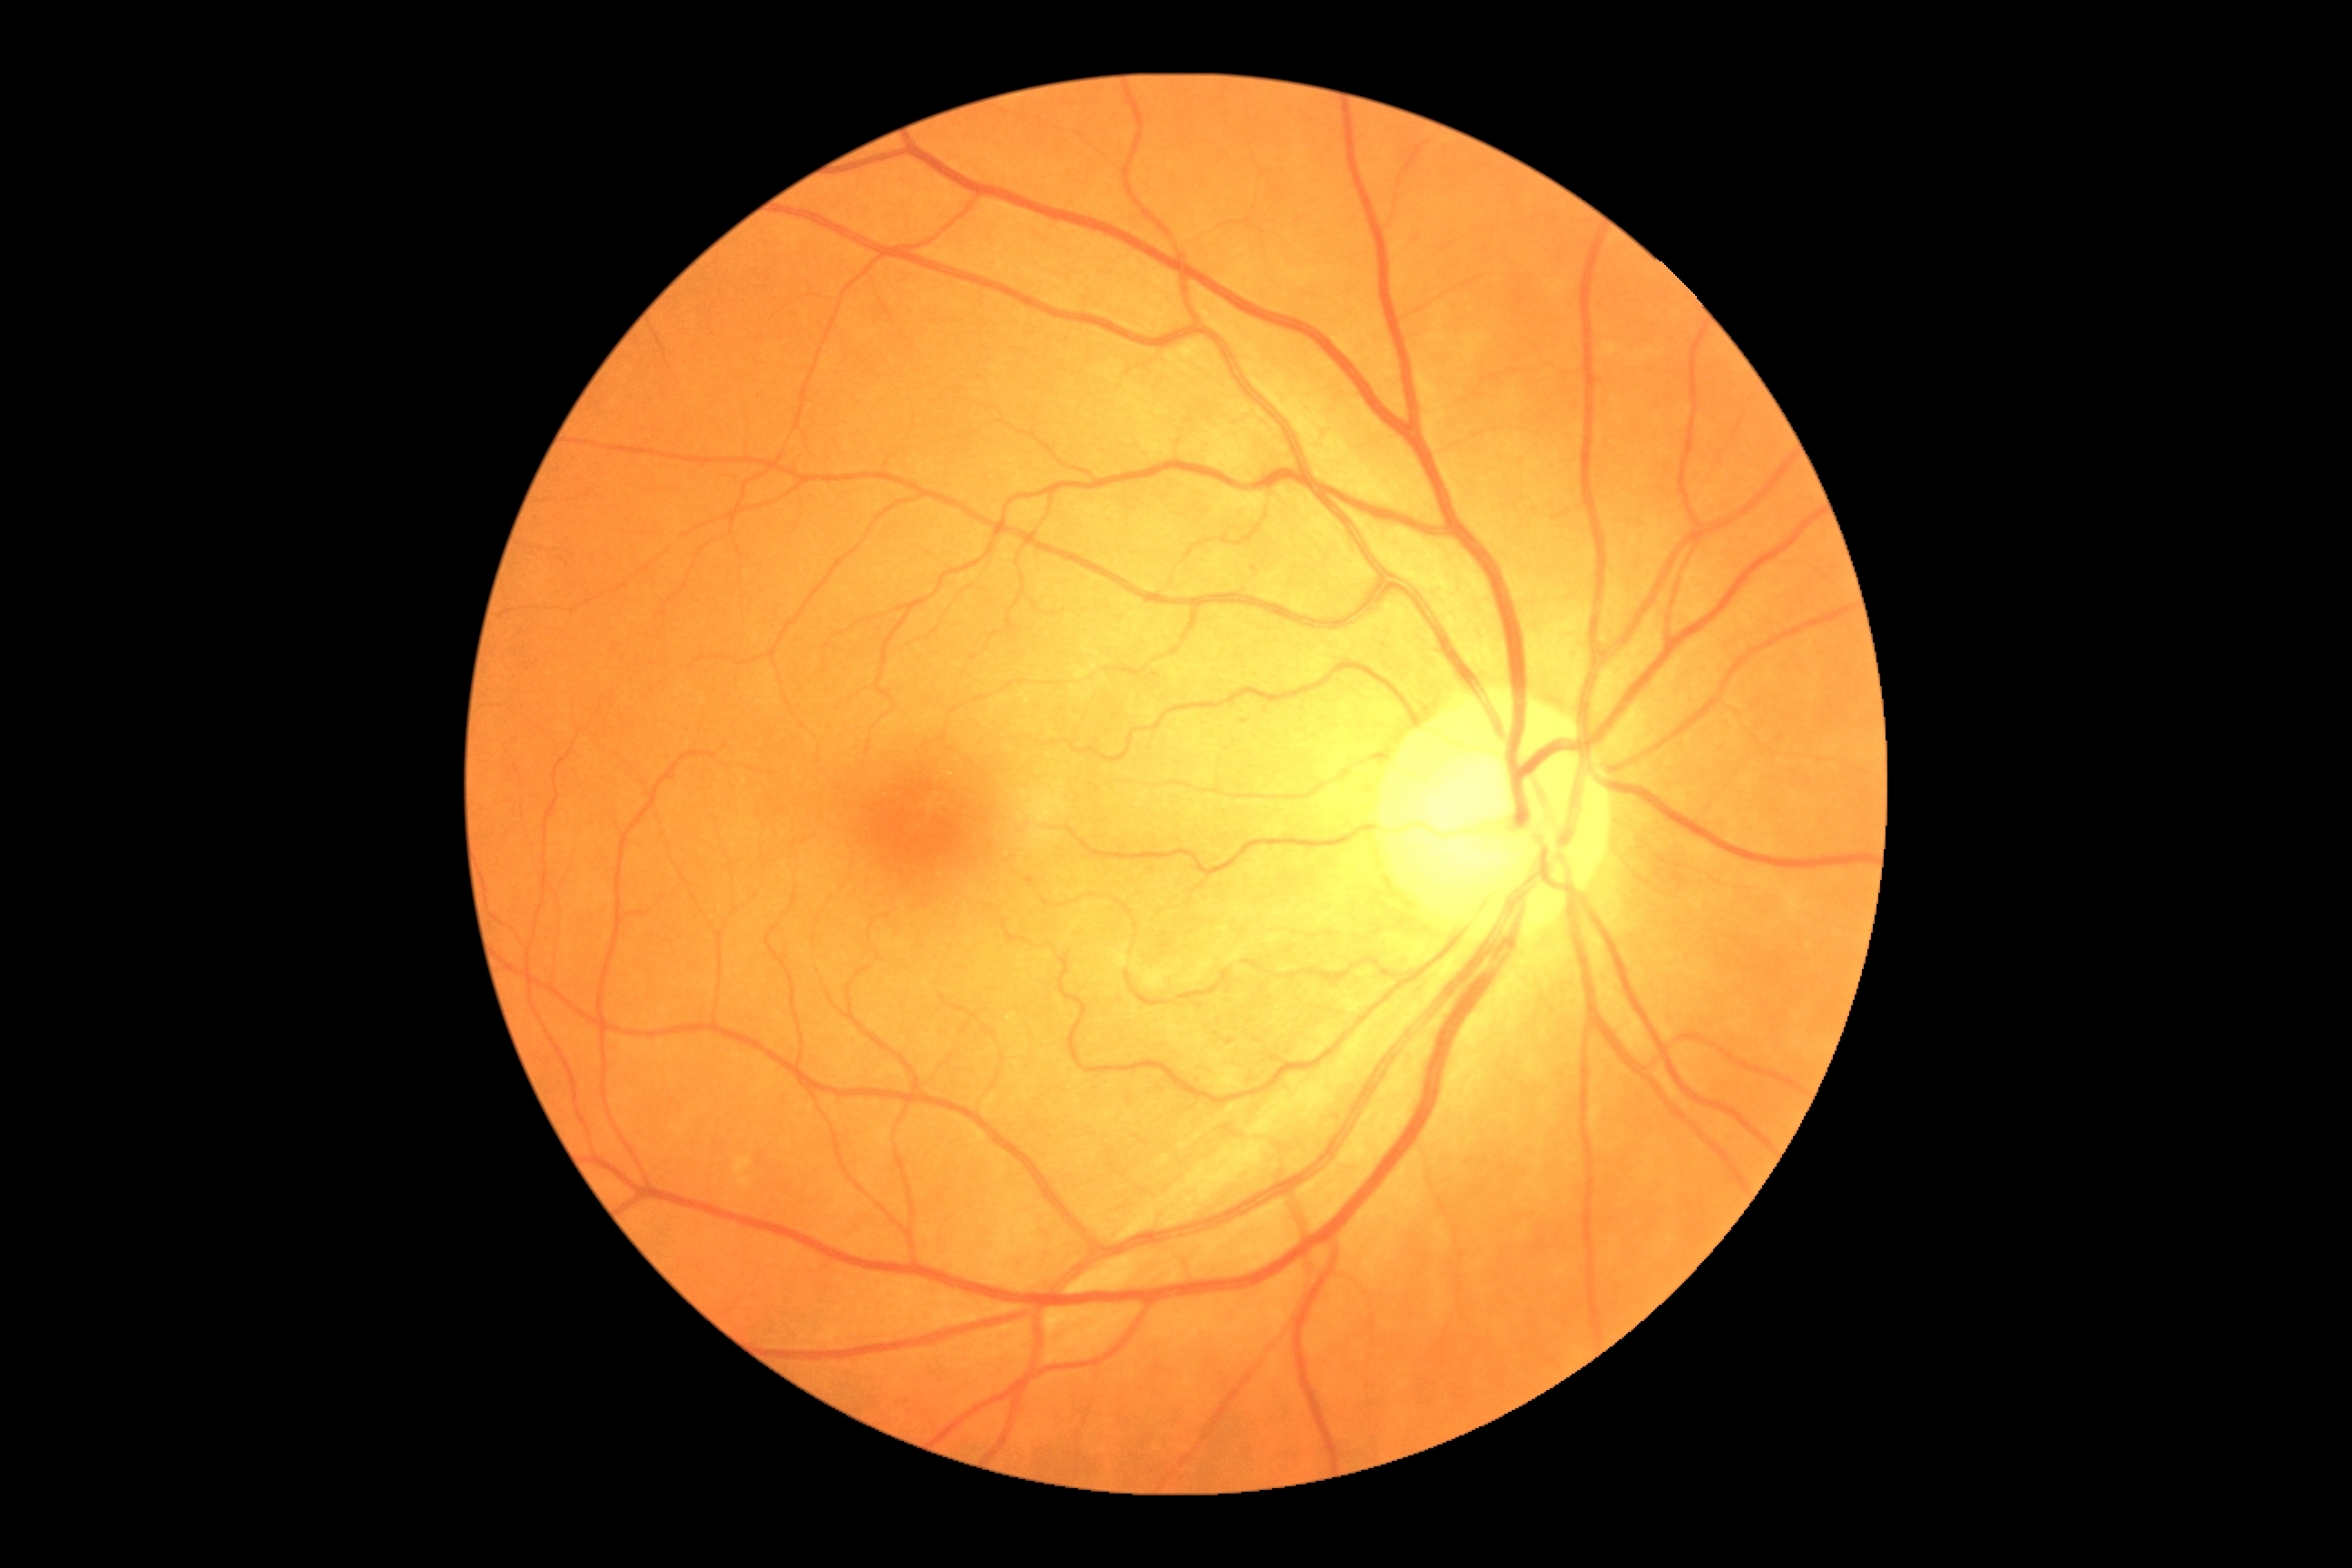
Retinopathy grade is 0 (no apparent retinopathy).